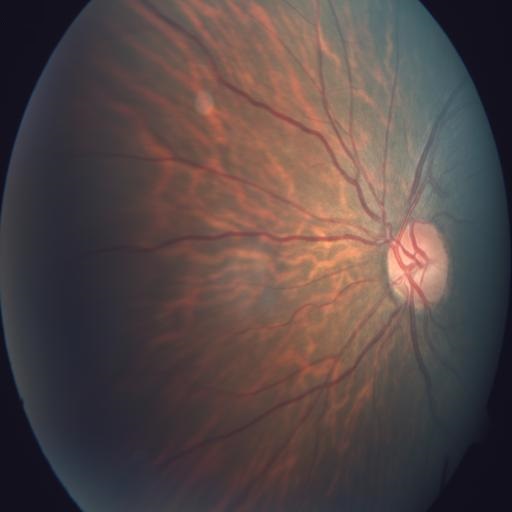
Diagnosis: tessellation (TSLN).